Phoenix ICON wide-field infant fundus image. Captured with the Phoenix ICON (100° field of view):
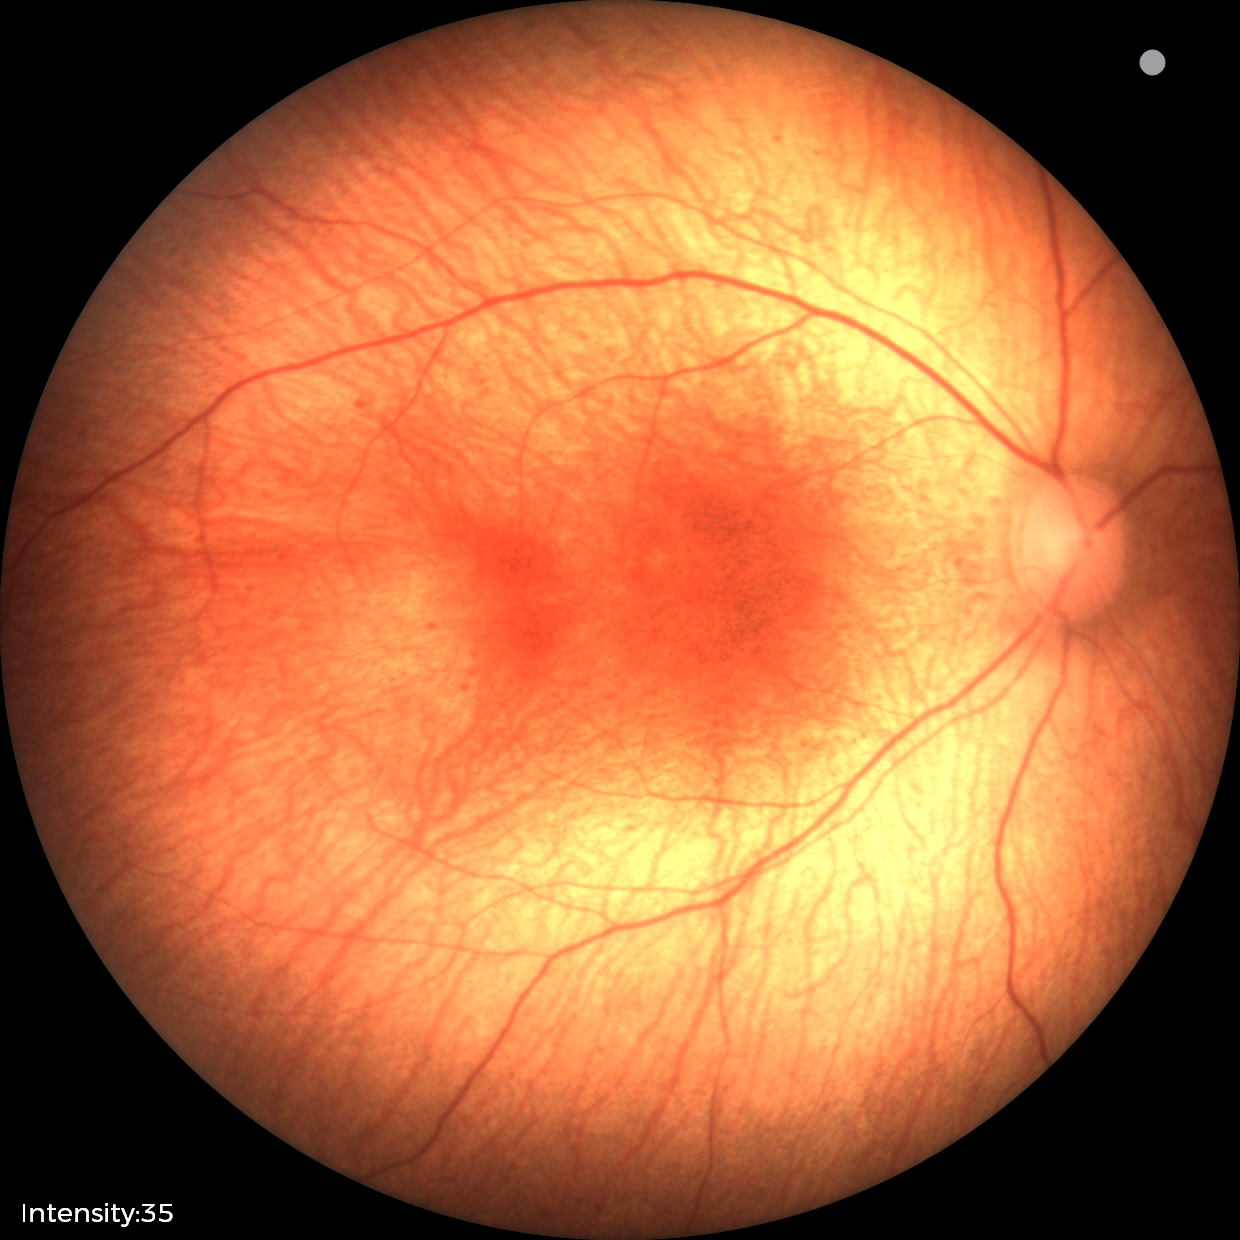
Assessment: no abnormal retinal findings.